Infant wide-field fundus photograph:
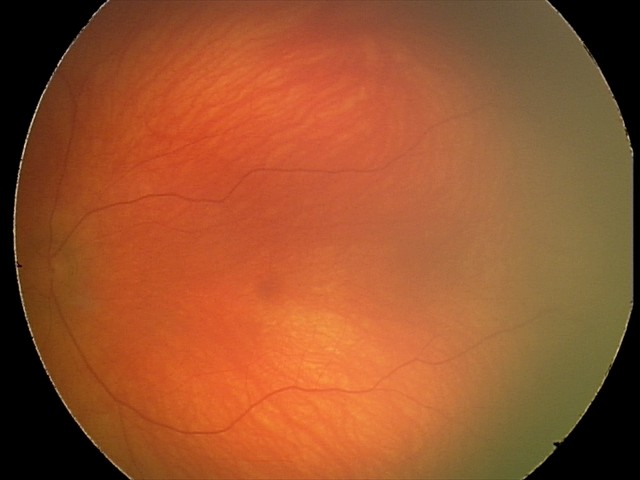
Assessment: physiological finding.